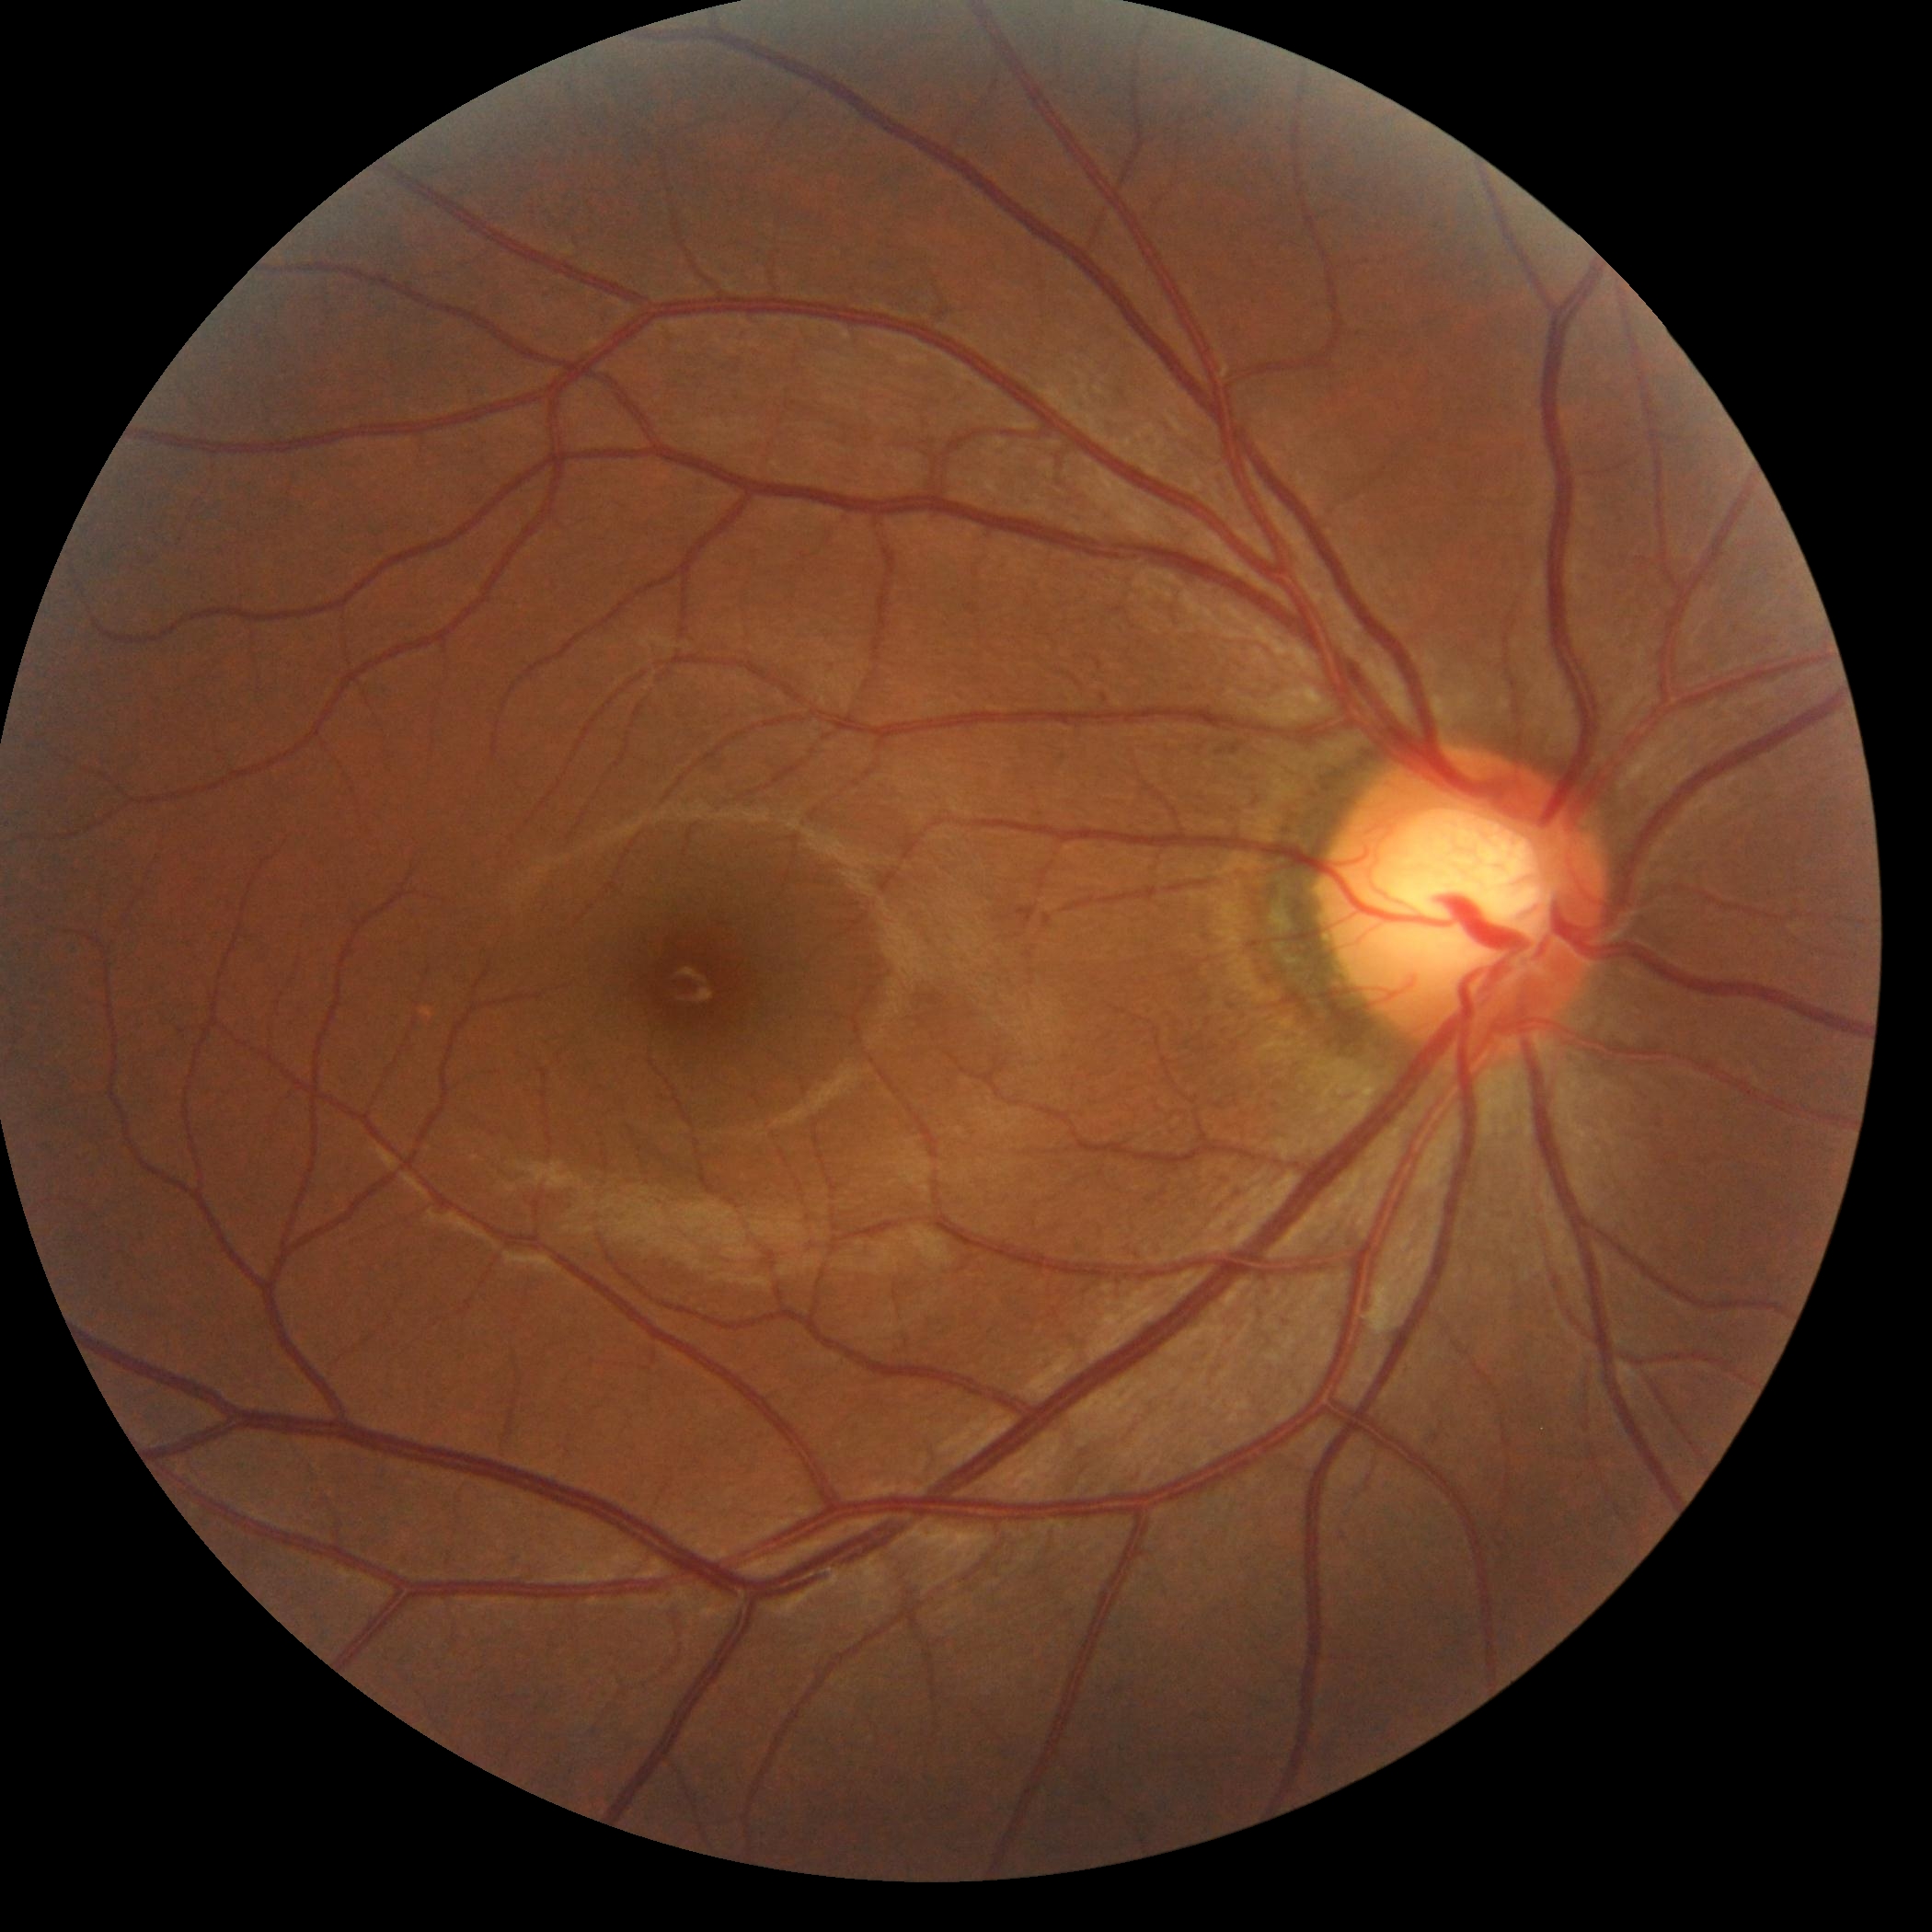
DR grade is 0 (no apparent retinopathy) — no visible signs of diabetic retinopathy.